2089x1764.
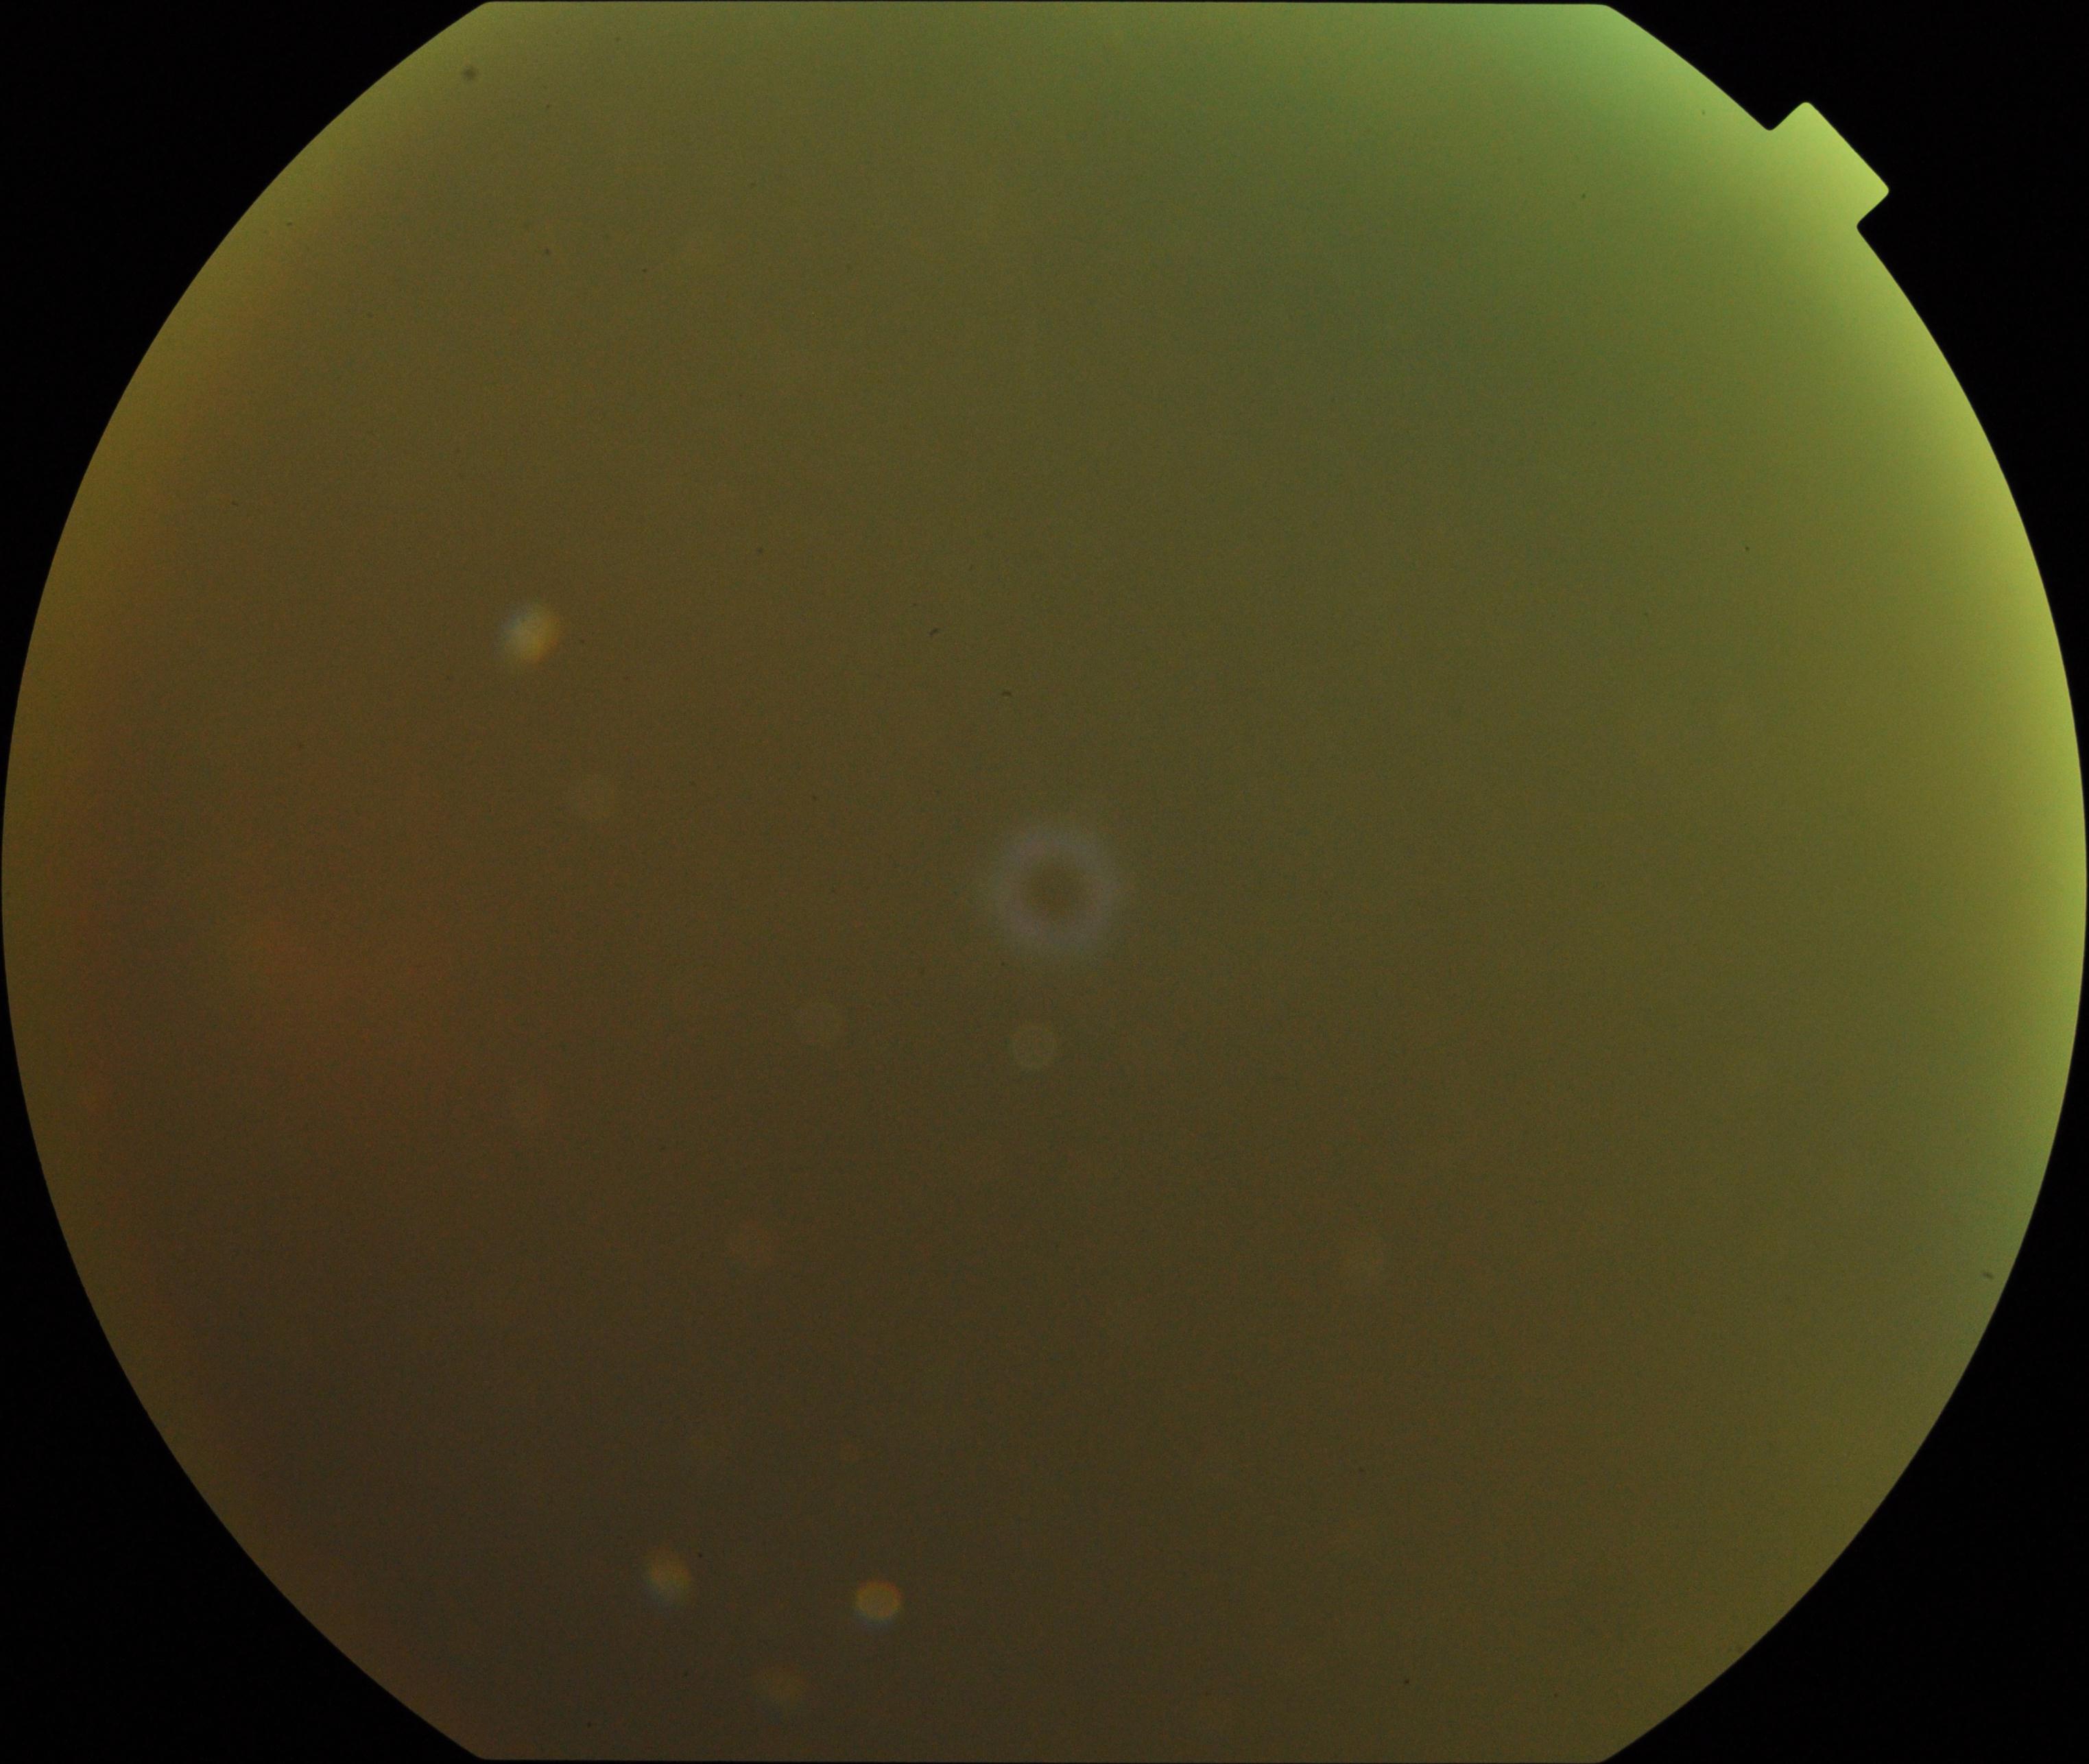
Blurred fundus image with substantial obscuration of retinal landmarks. Proliferative diabetic retinopathy not identified in the visible portion.